45° FOV: 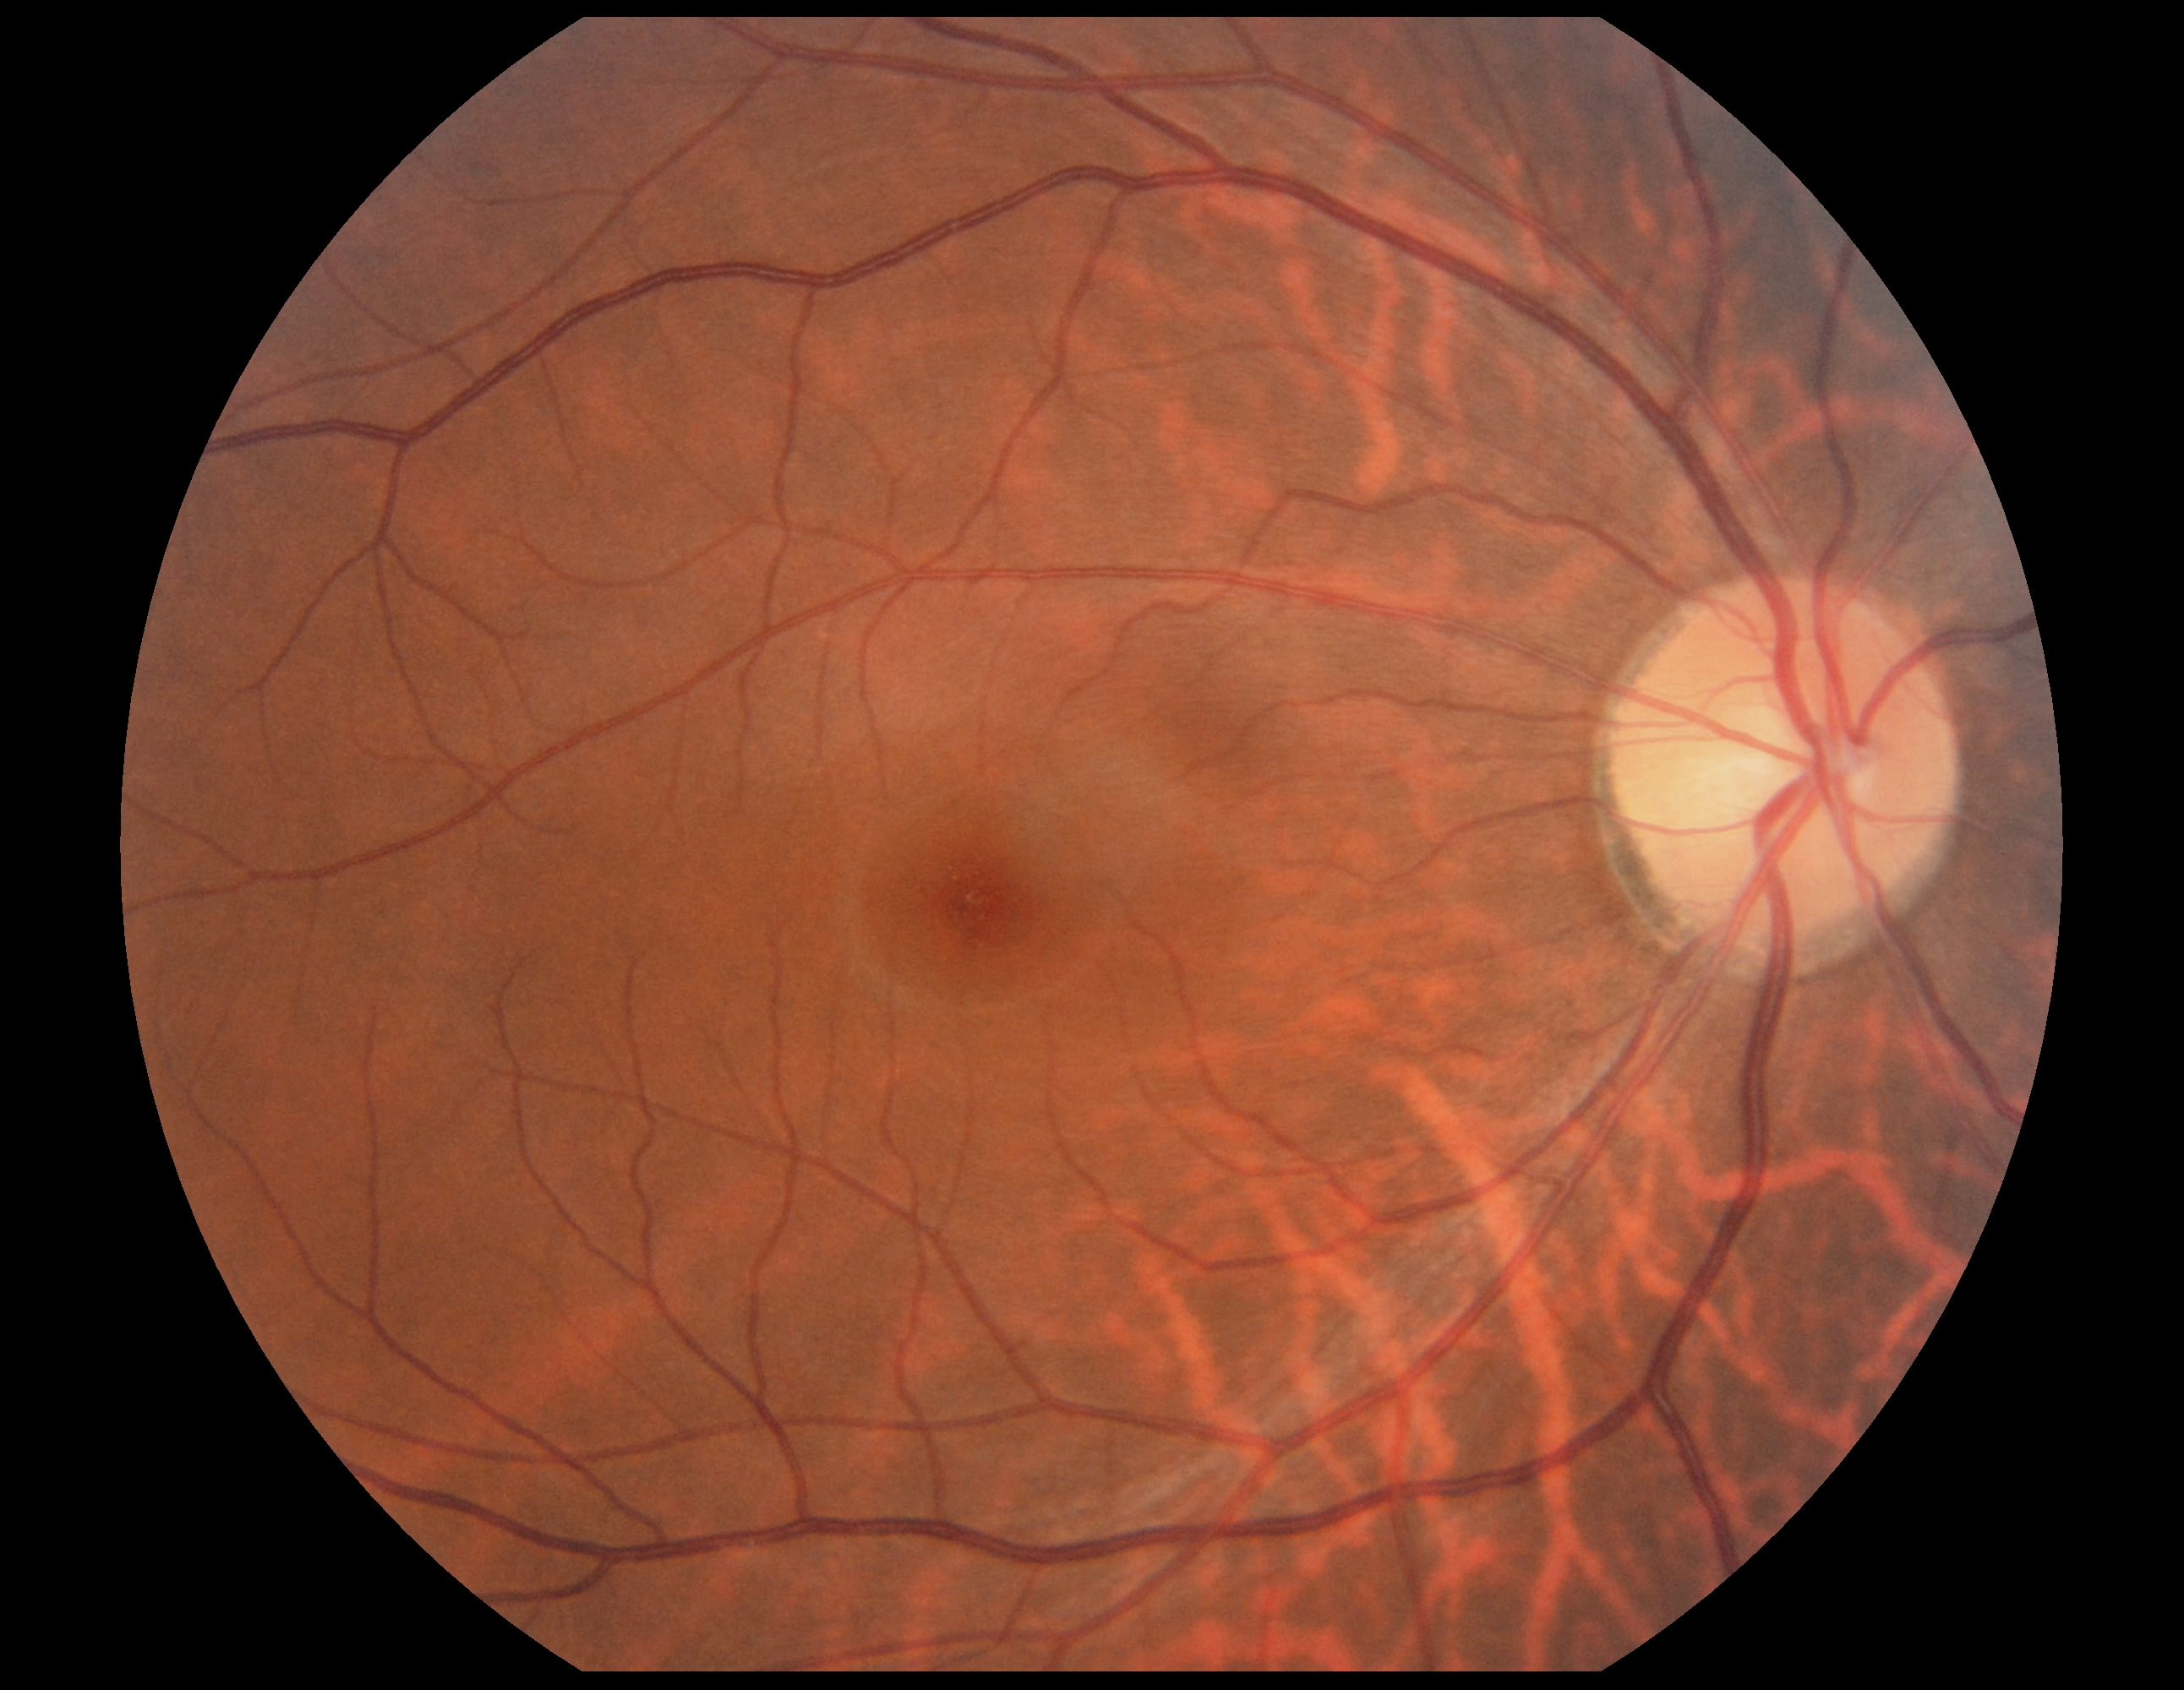
Diabetic retinopathy (DR) is 0/4. No DR findings.